Camera: Remidio smartphone fundus camera
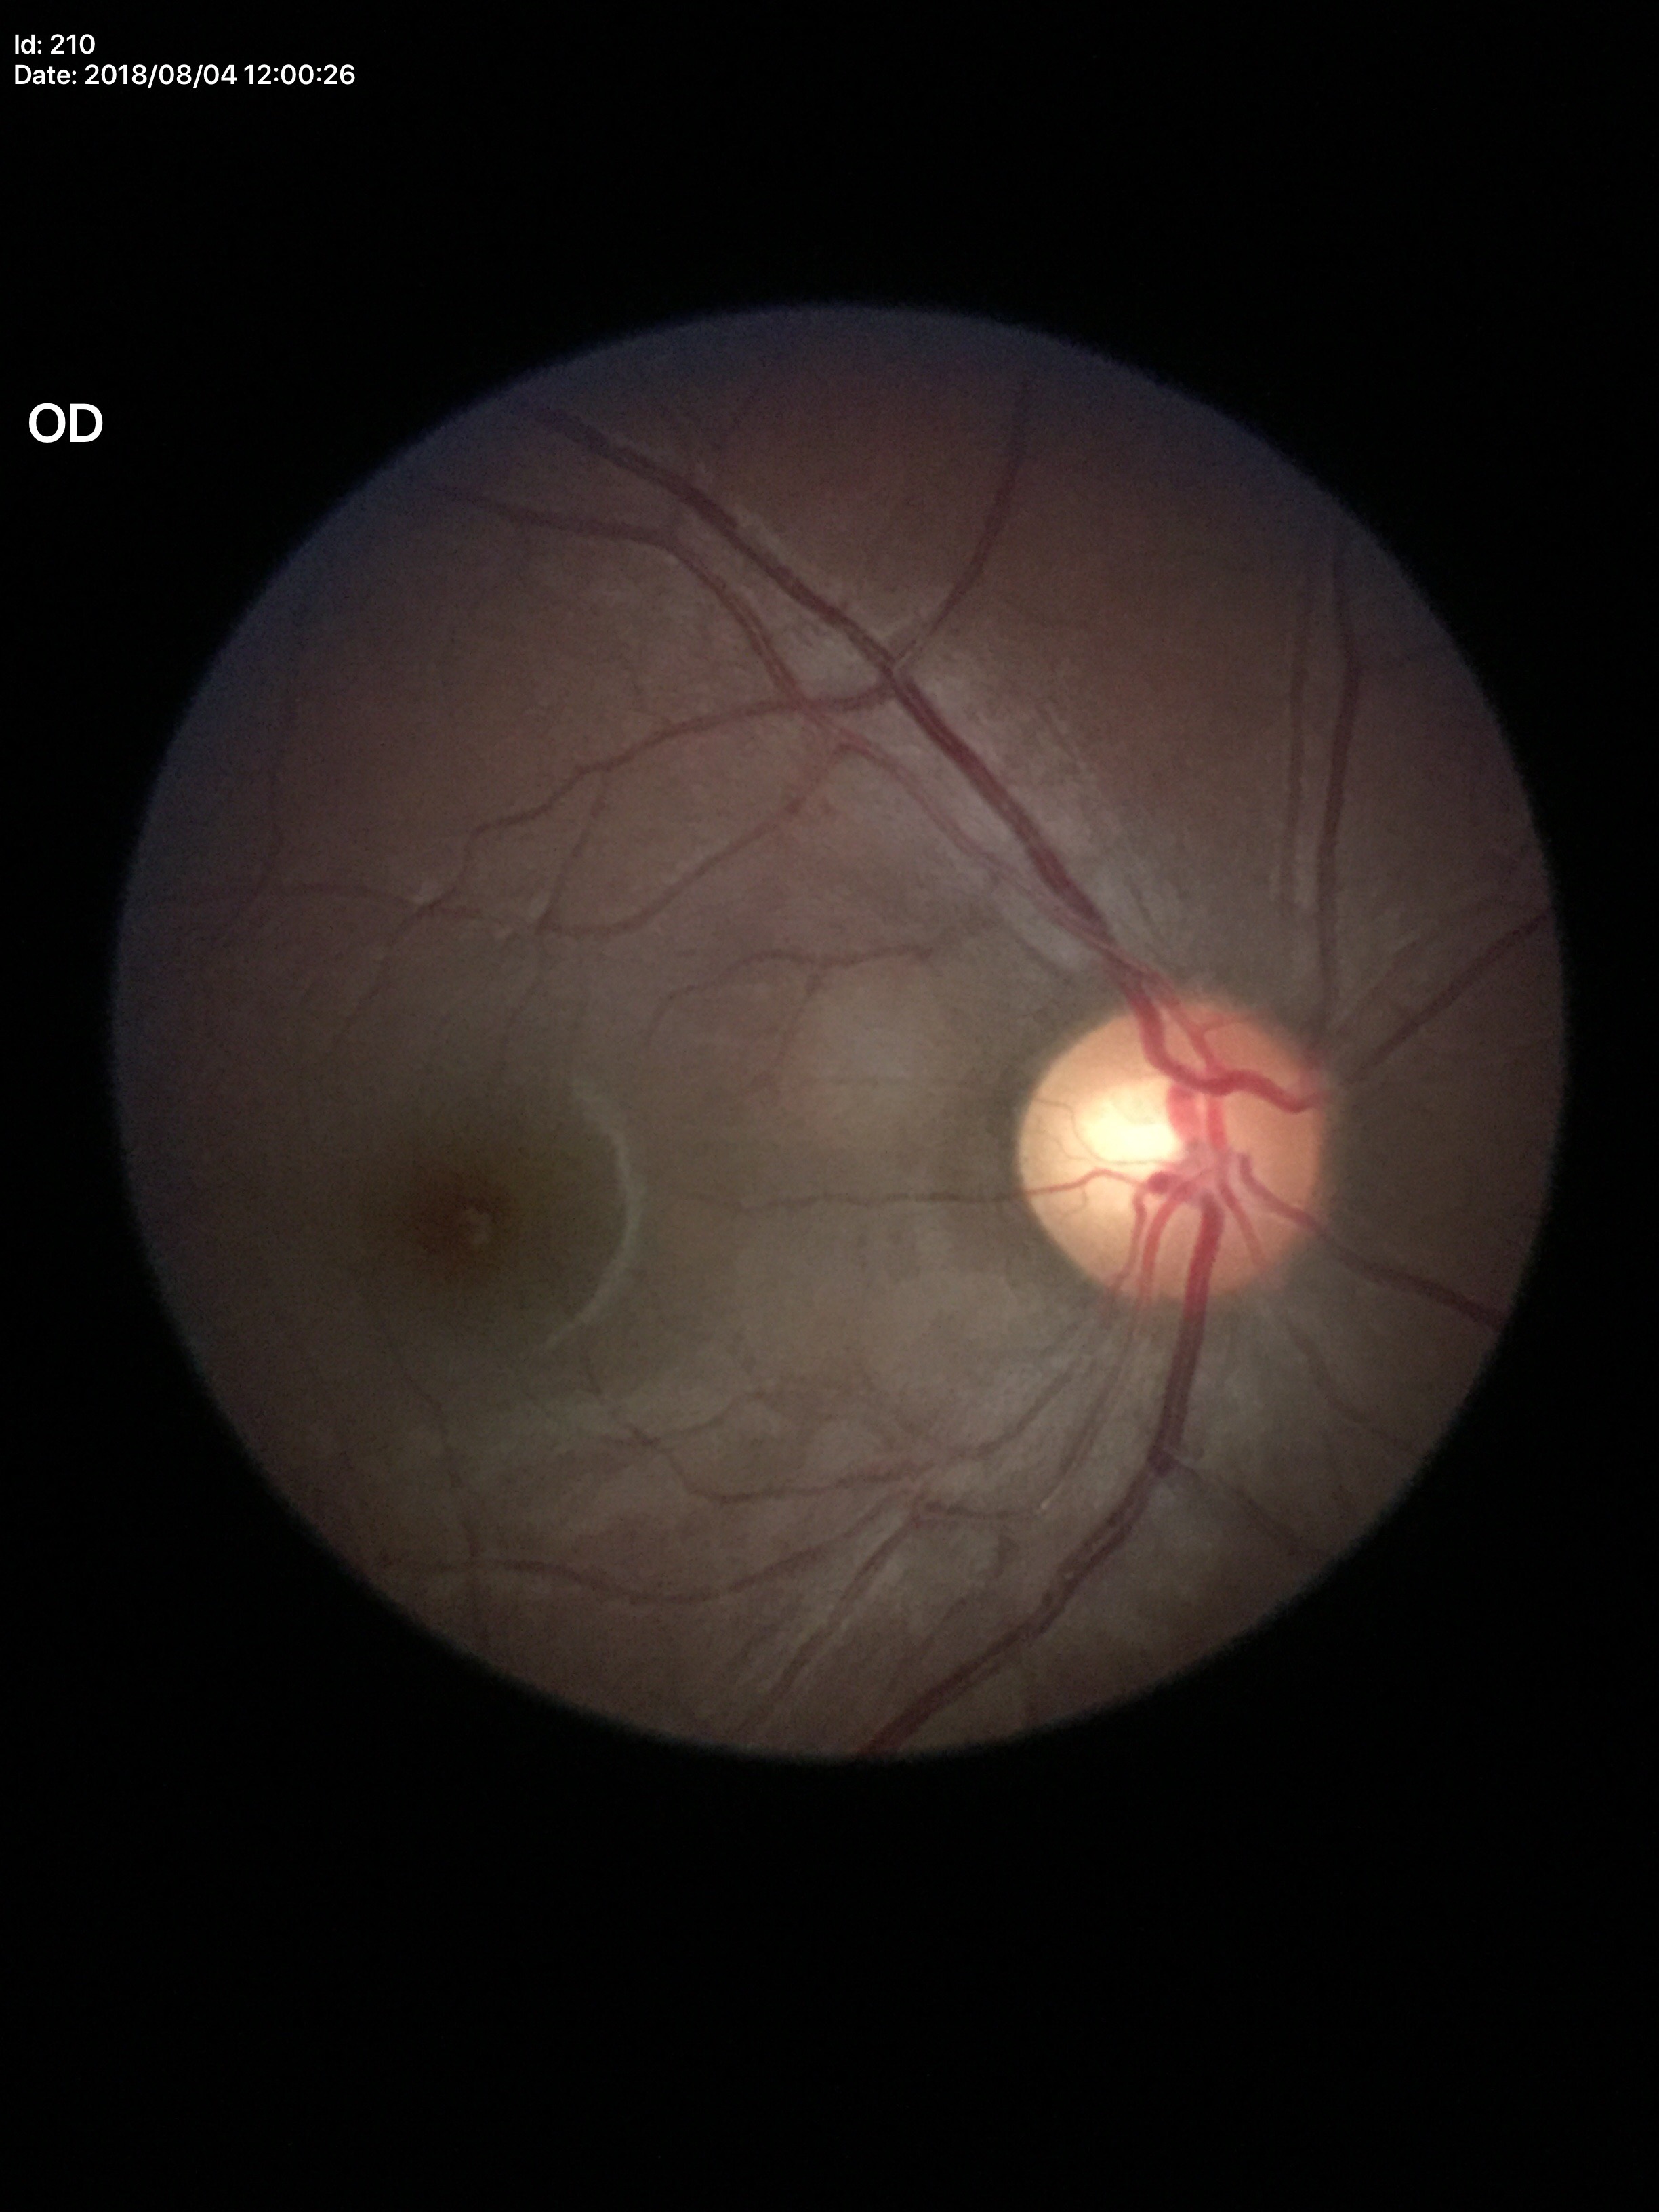 Glaucoma screening impression: negative; vertical cup-to-disc ratio (VCDR): 0.60; horizontal C/D ratio (HCDR): 0.63